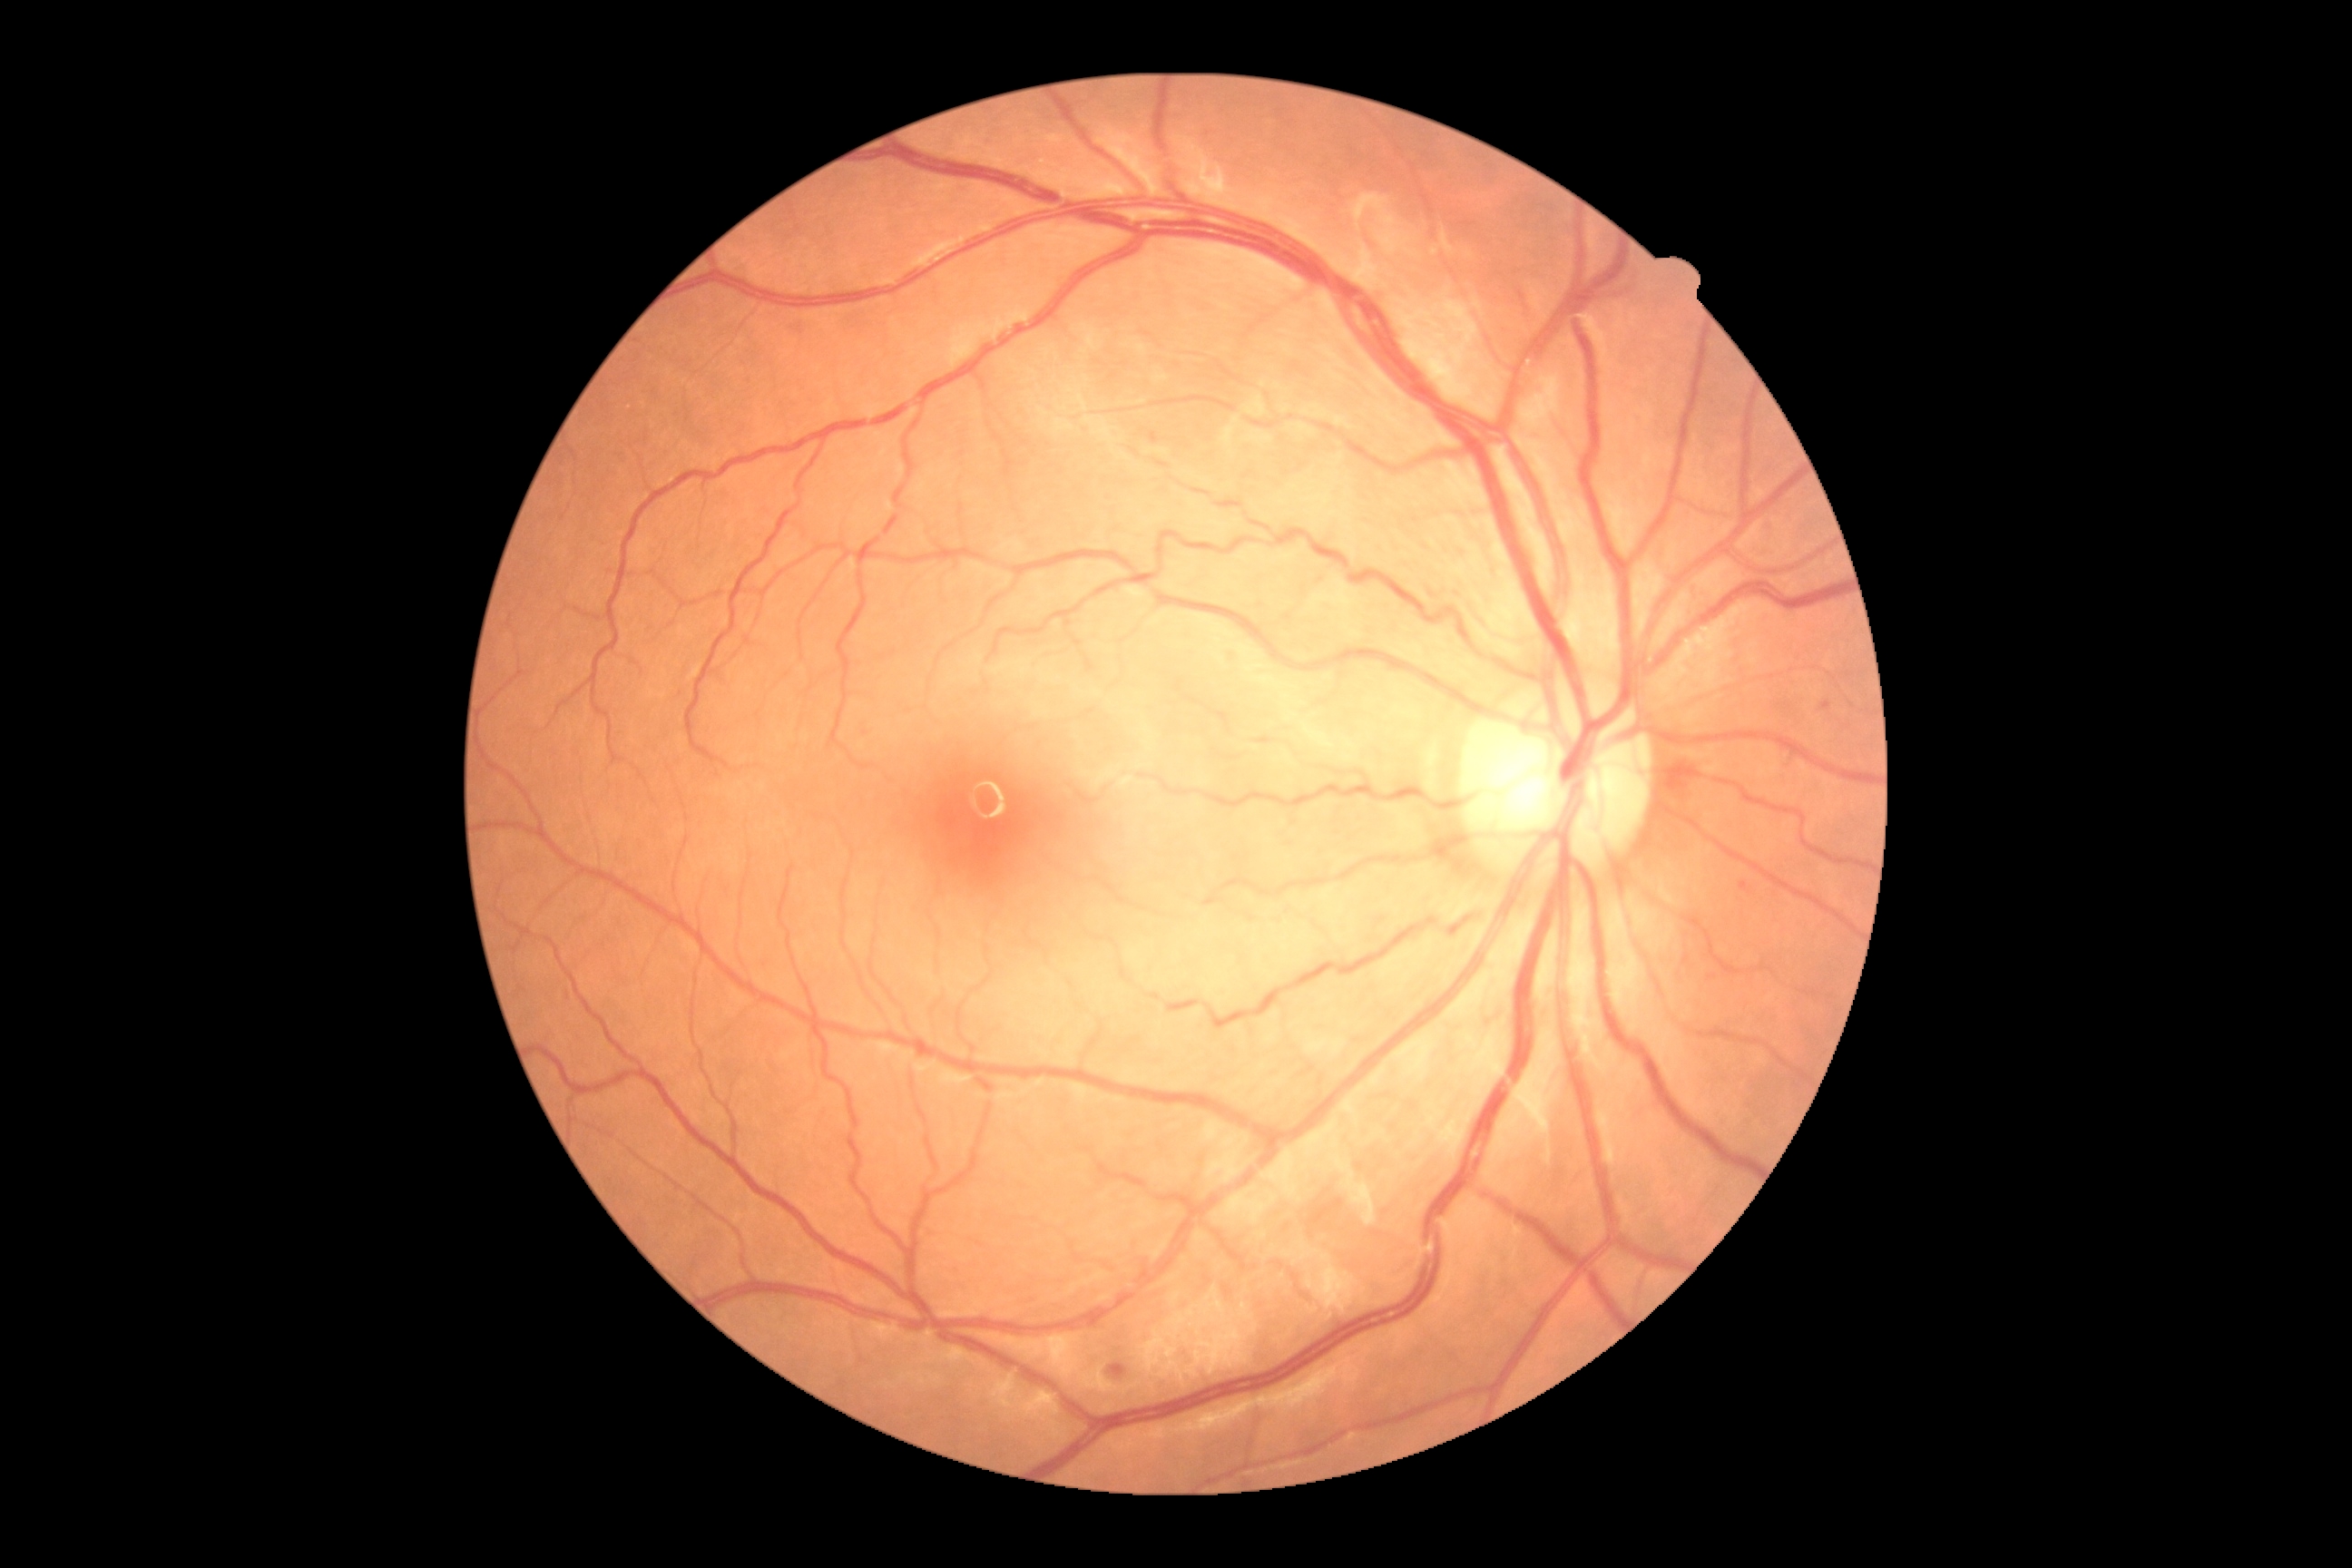
Annotations:
– DR — moderate non-proliferative diabetic retinopathy (grade 2)